Color fundus image
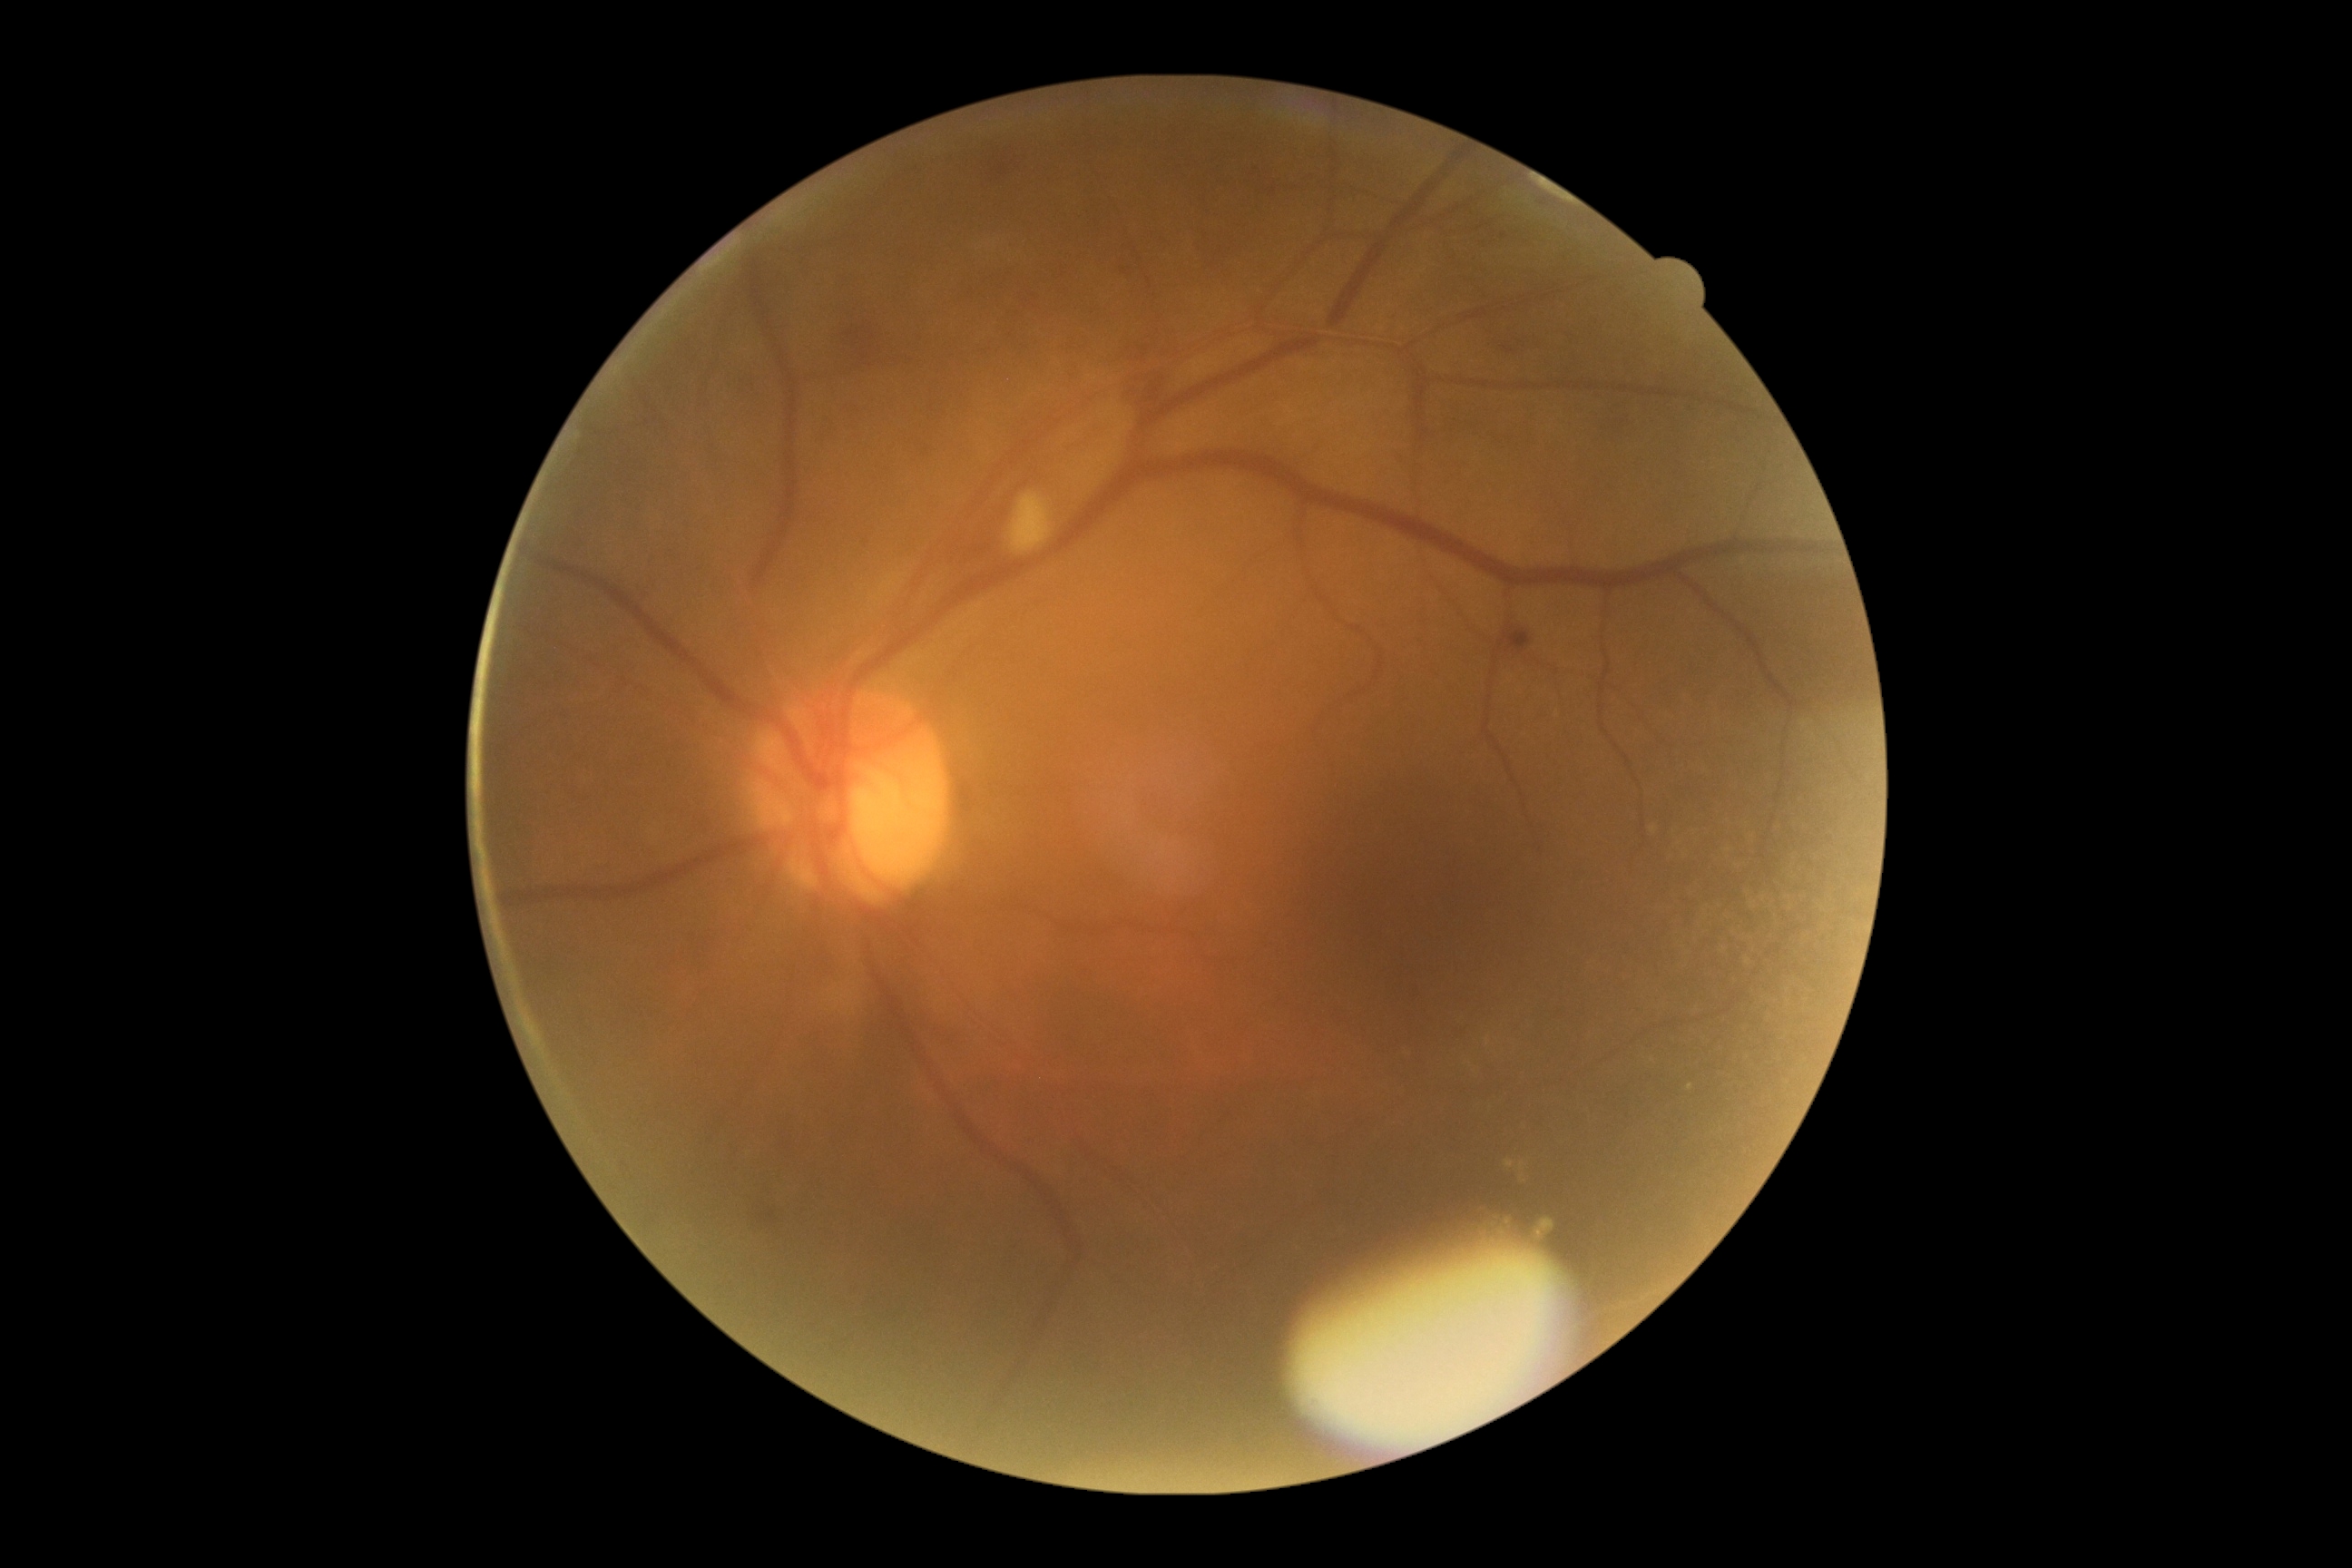
diabetic retinopathy severity = 2.